Retinal fundus photograph. Dilated-pupil acquisition.
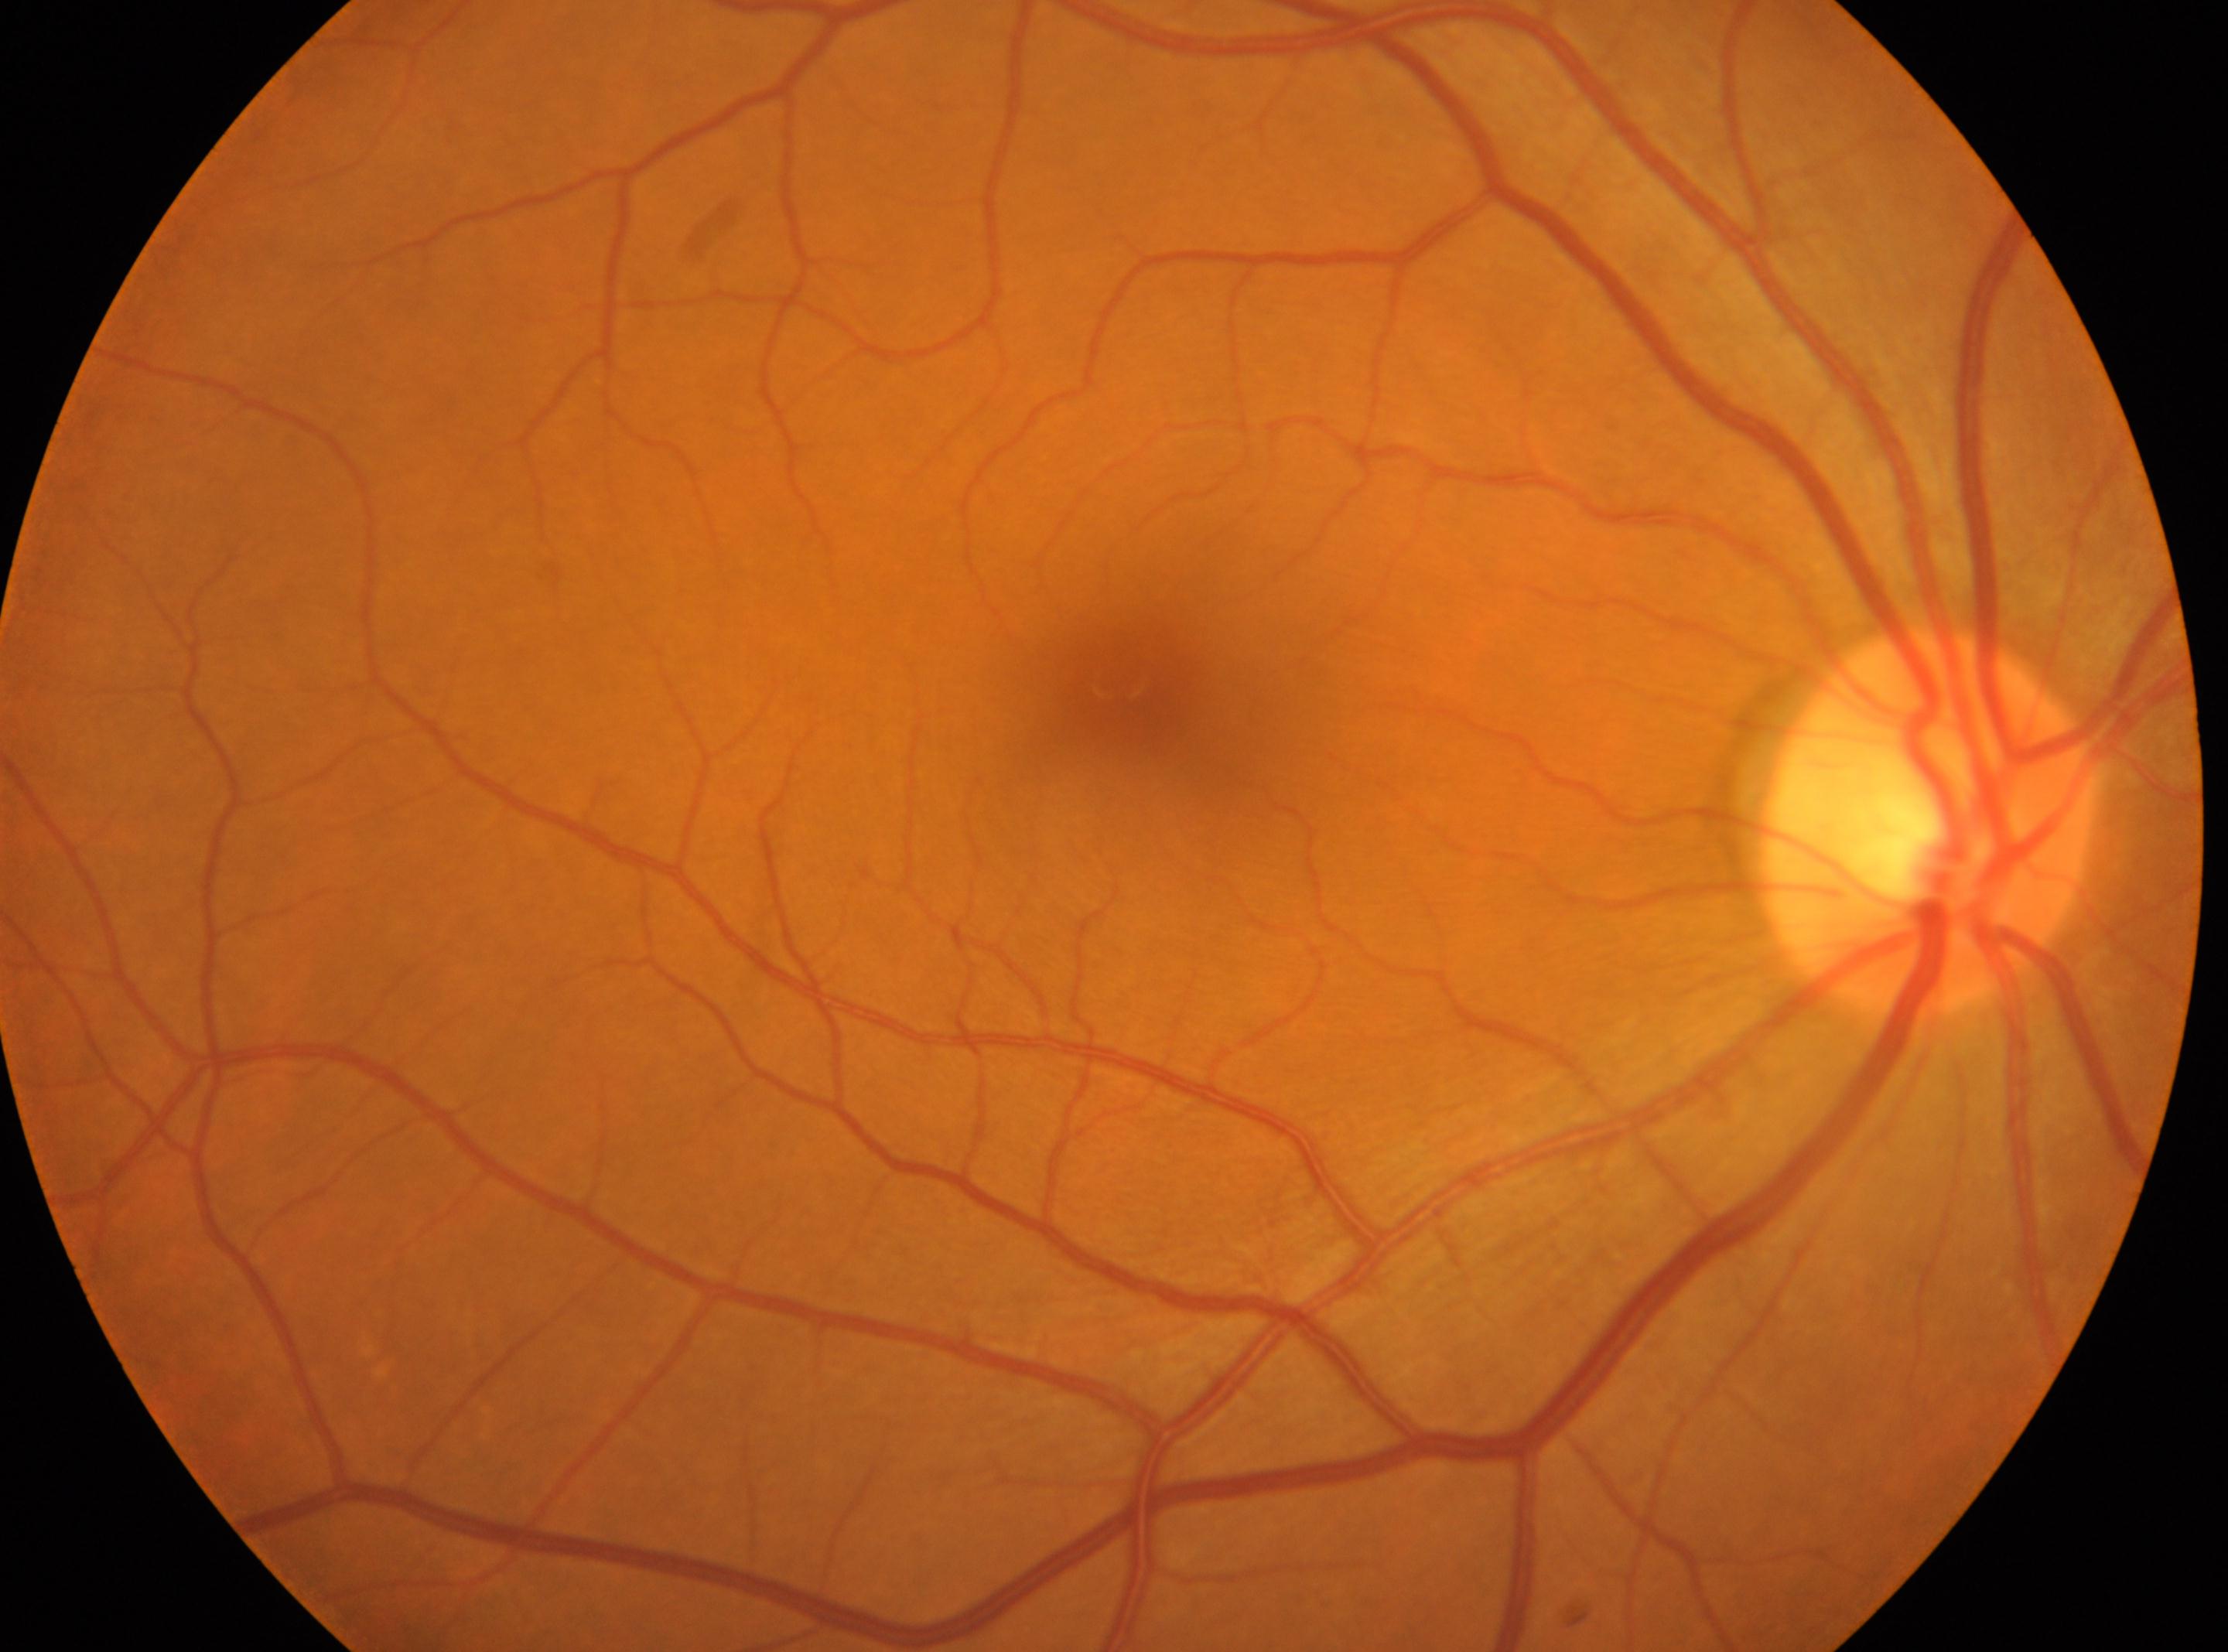 the fovea: (1116,679)
ONH: (1928,821)
laterality: right eye
DR stage: grade 0 (no apparent retinopathy)
DR impression: No apparent diabetic retinopathy